UWF retinal mosaic.
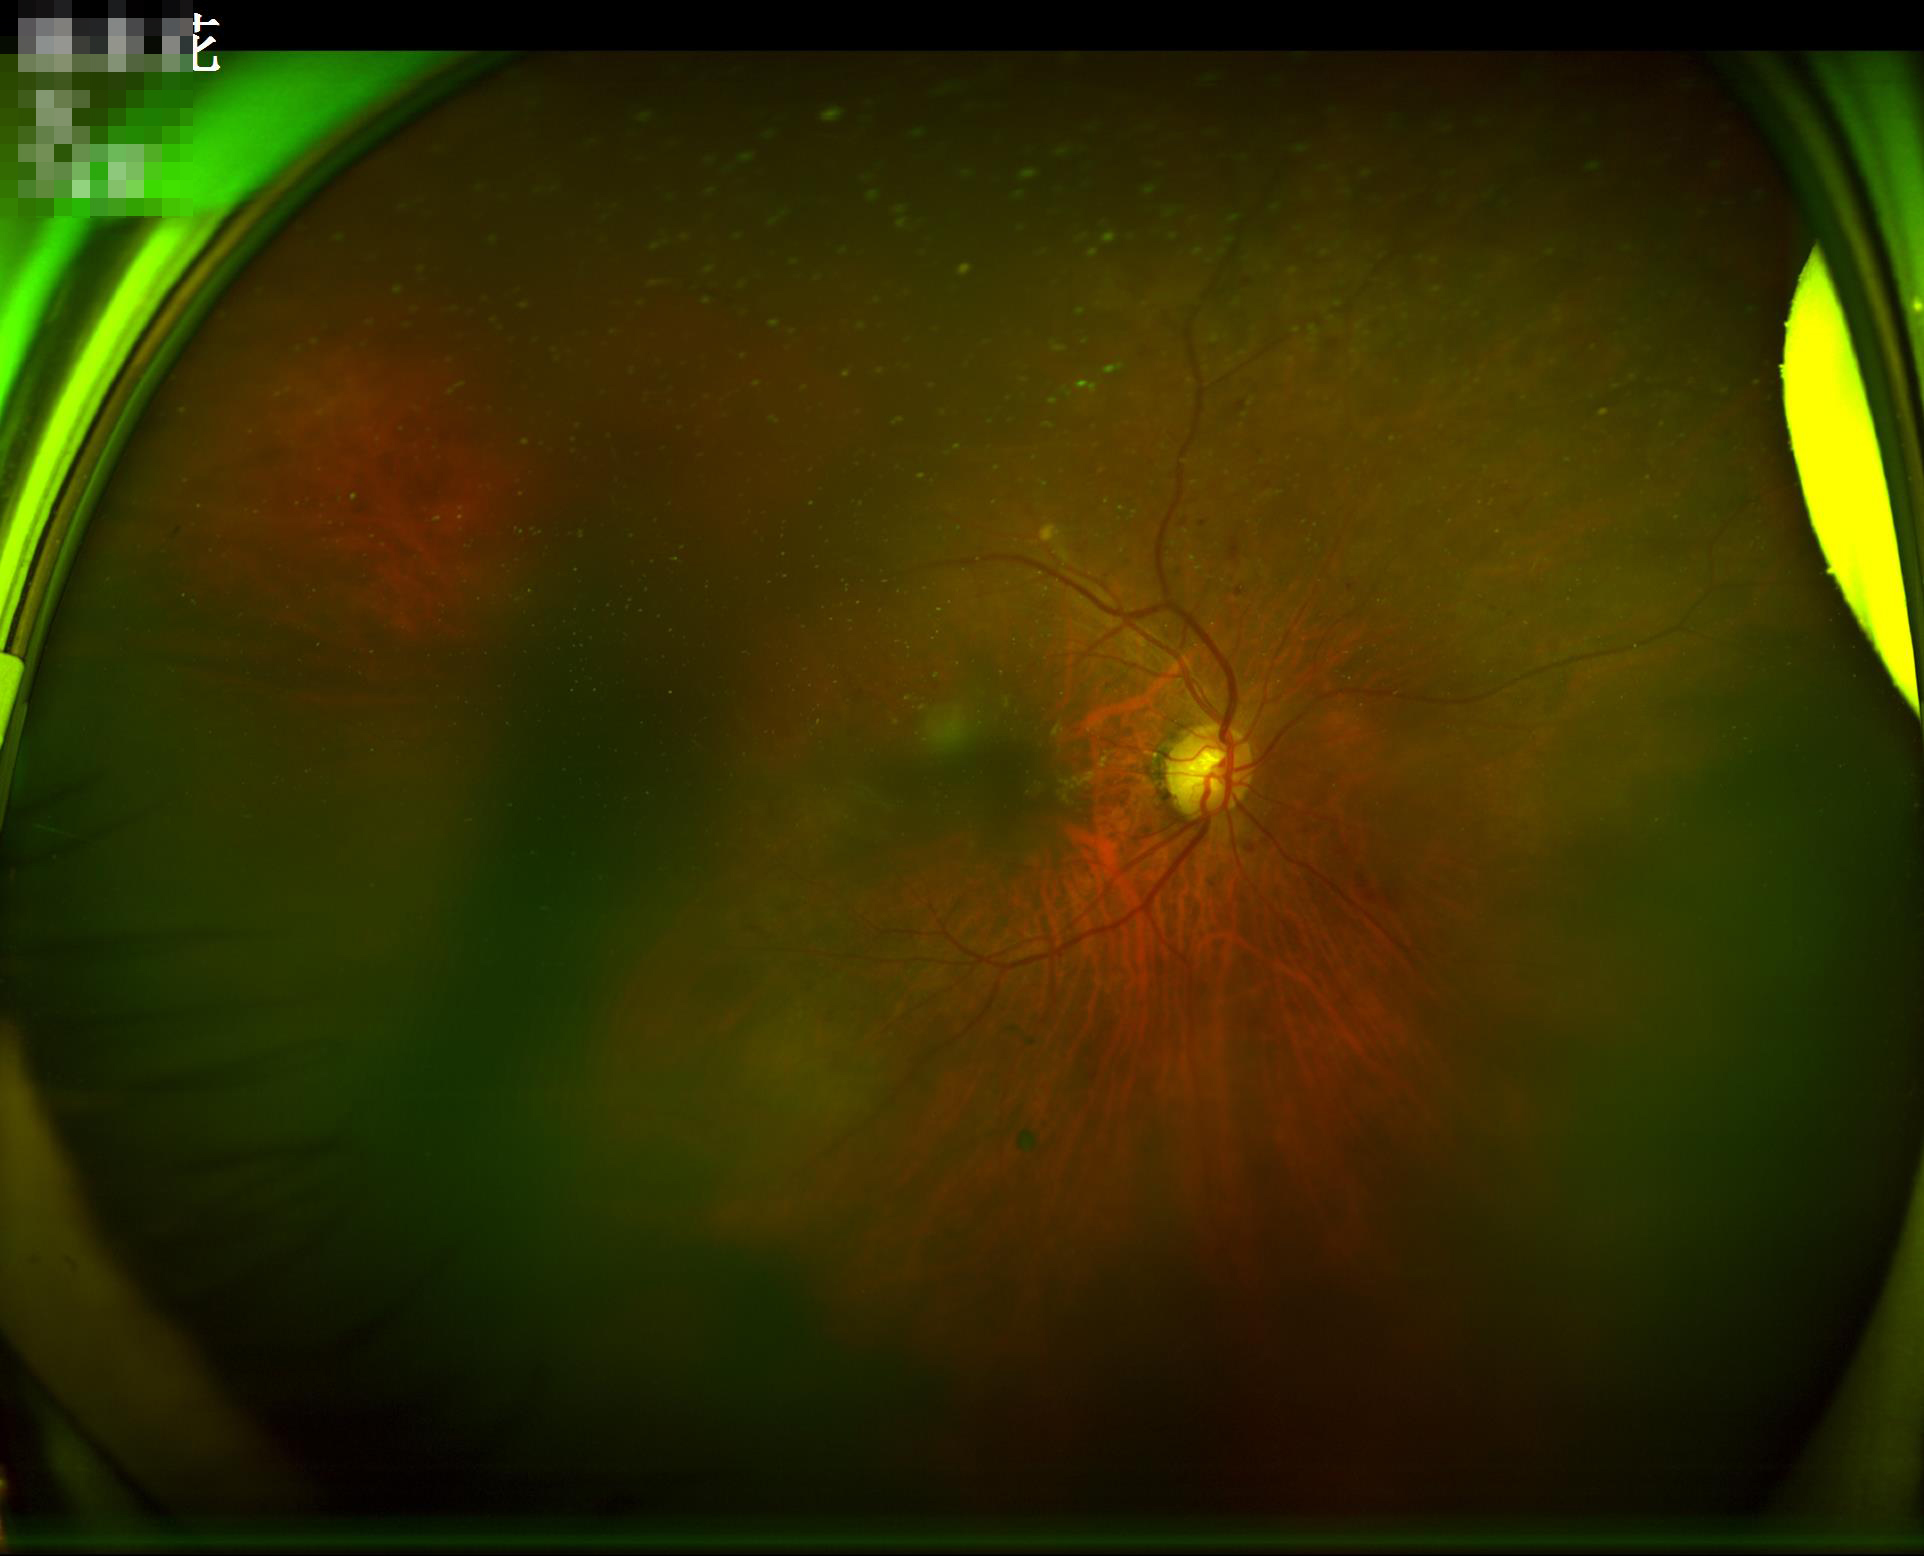

Overall quality is poor; the image is difficult to grade. Illumination is uneven. Noticeable blur in the optic disc, vessels, or background. Adequate contrast for distinguishing structures.